Captured with the Natus RetCam Envision (130° field of view) · infant wide-field retinal image:
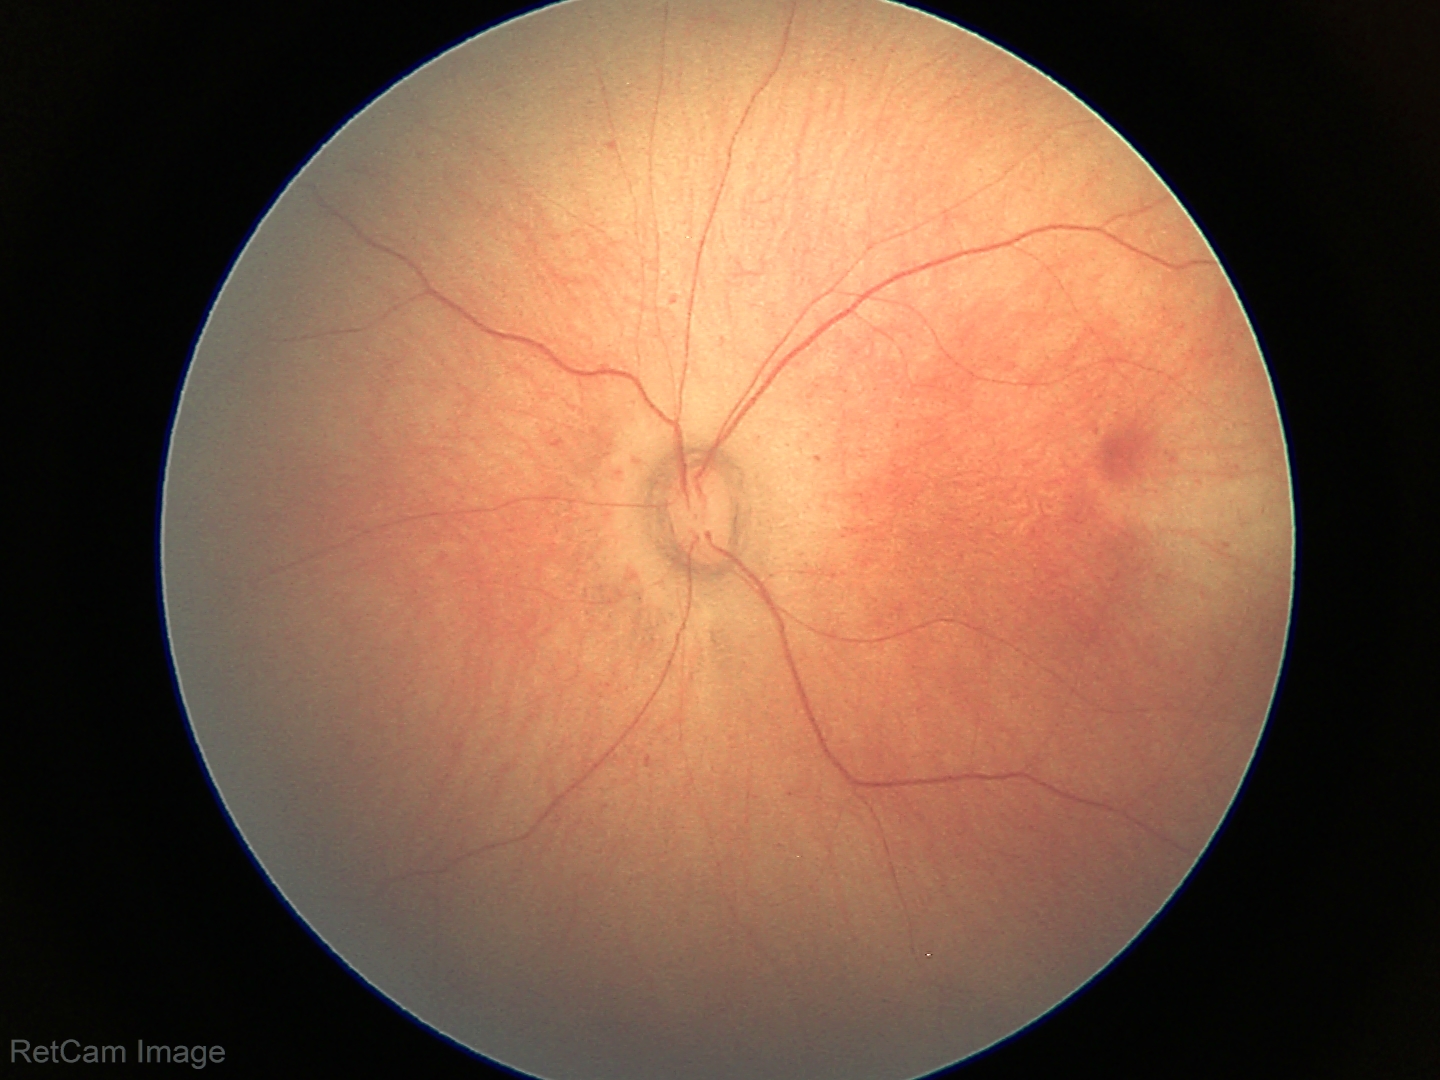
Physiological retinal appearance for postconceptual age.